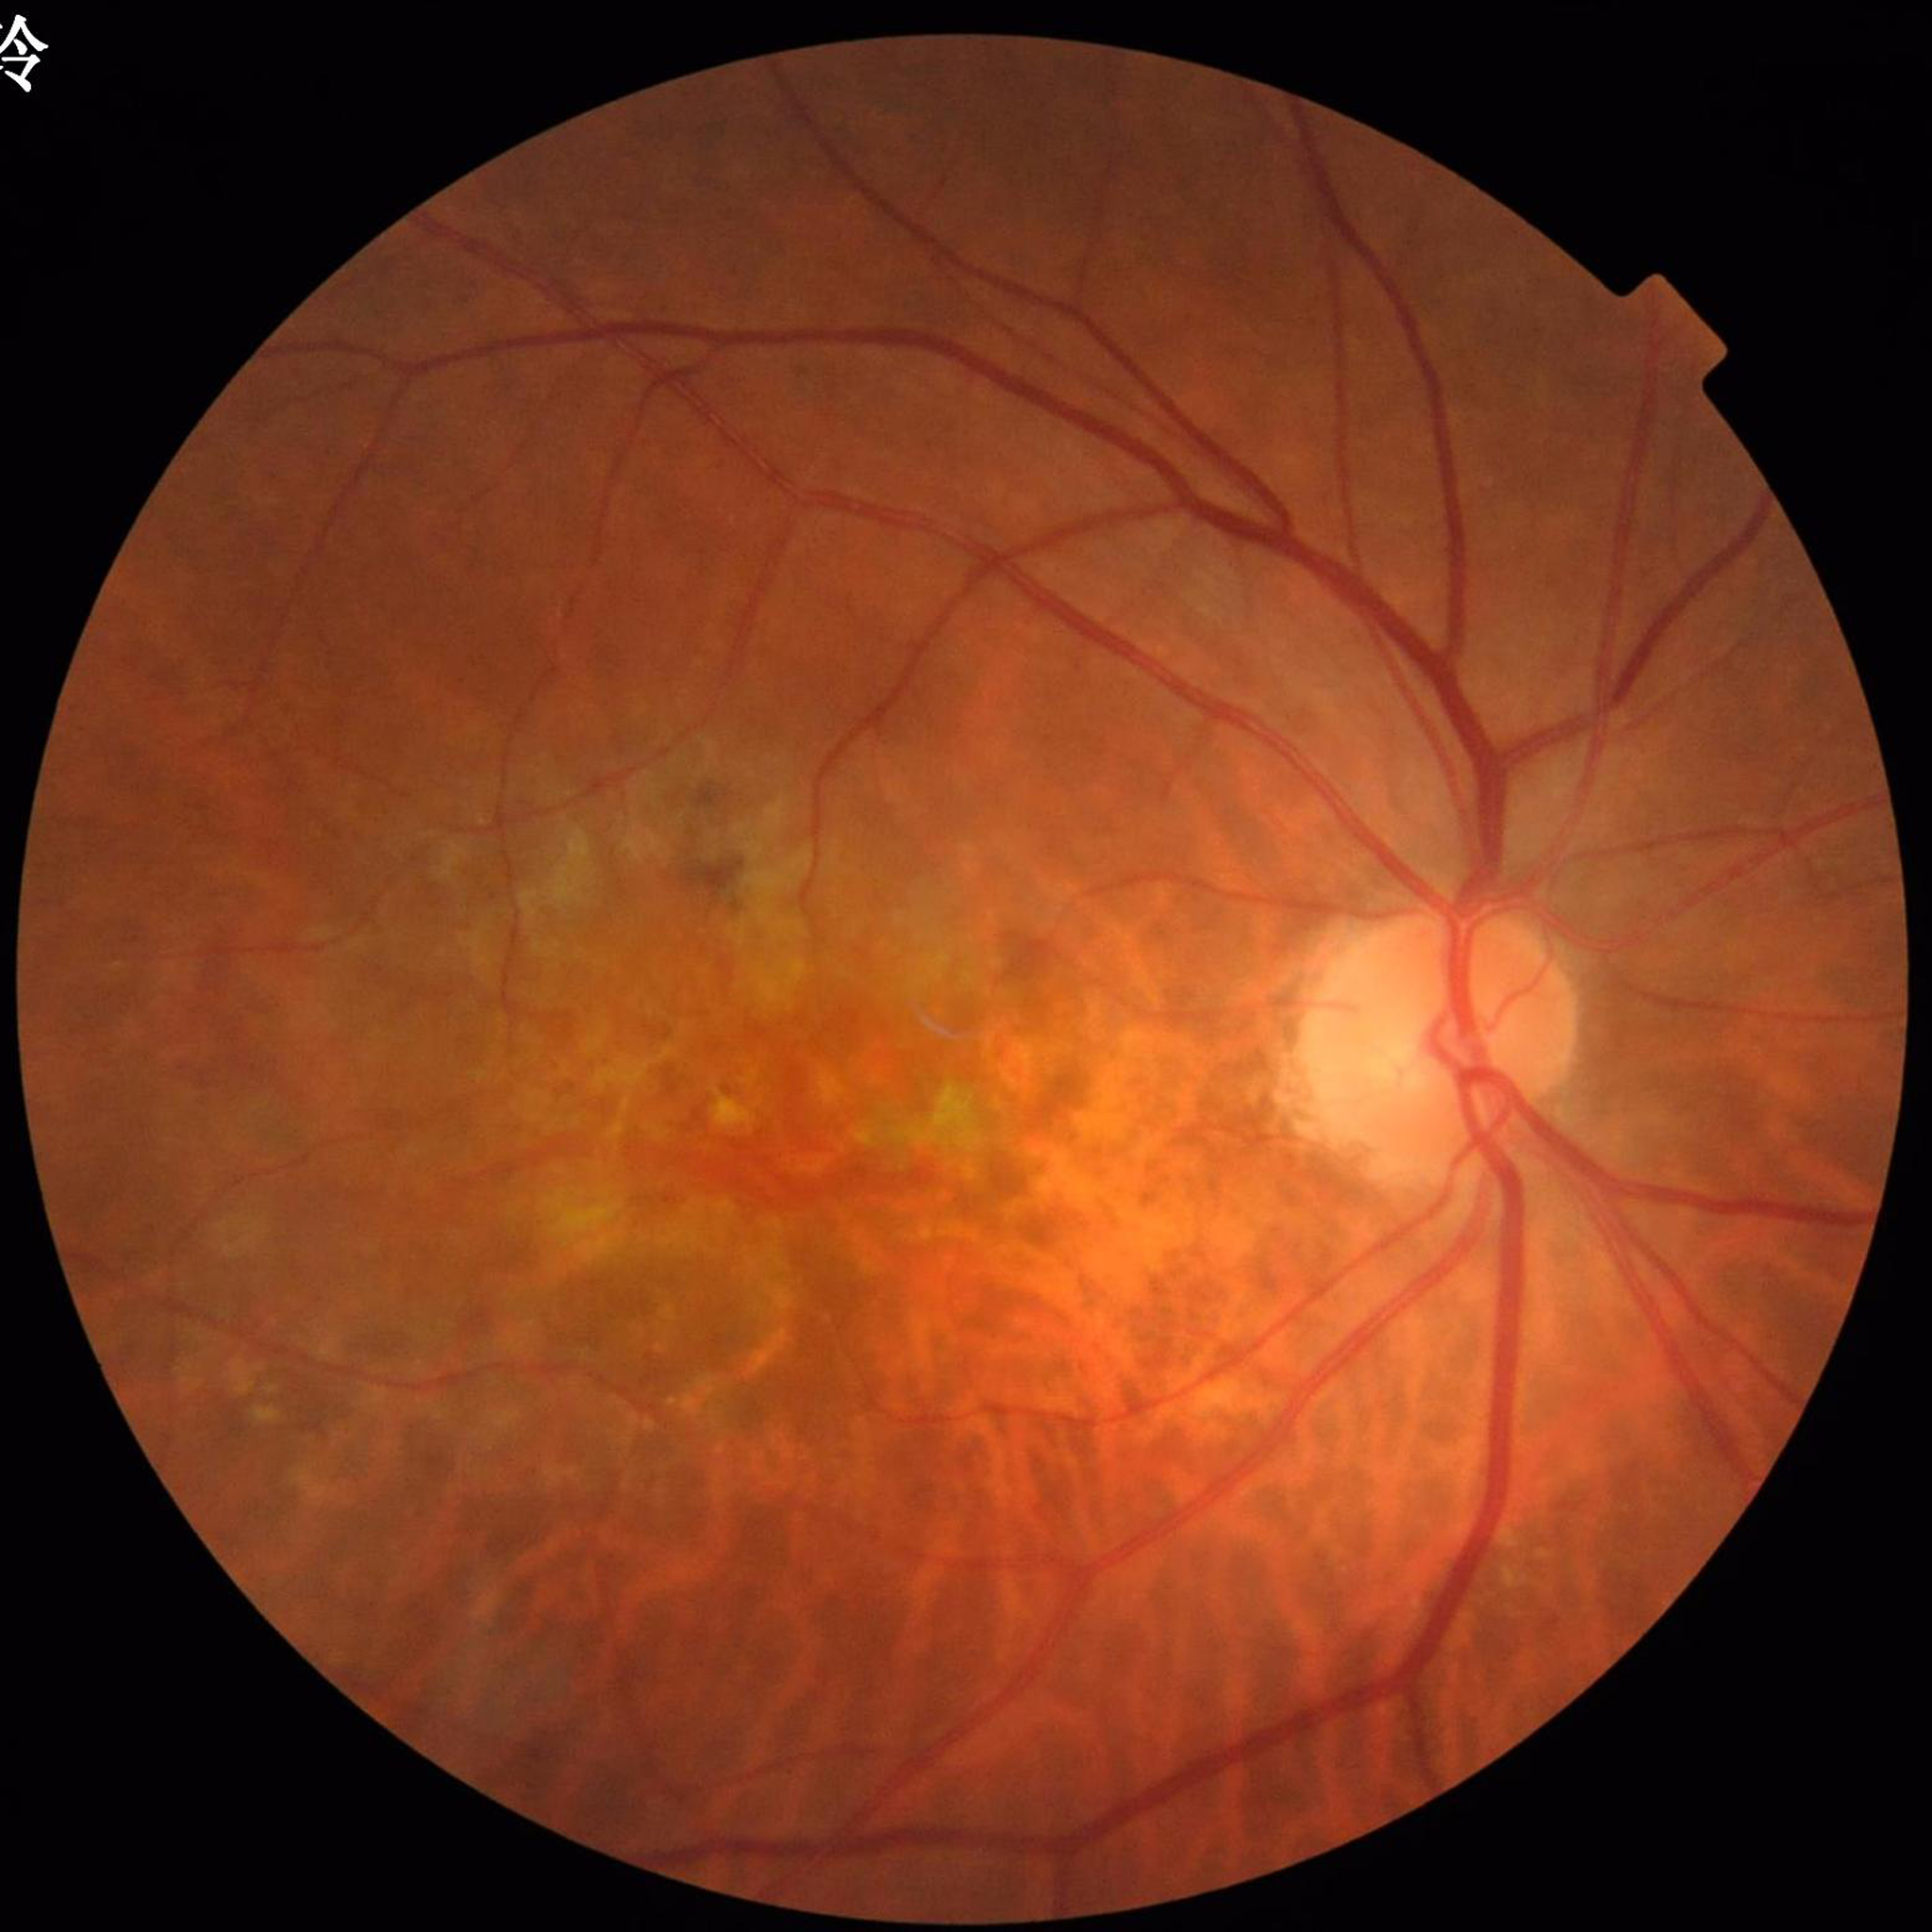
Quality: no quality issues identified | Diagnosis: age-related macular degeneration.